DR severity per modified Davis staging. No pharmacologic dilation. Posterior pole photograph:
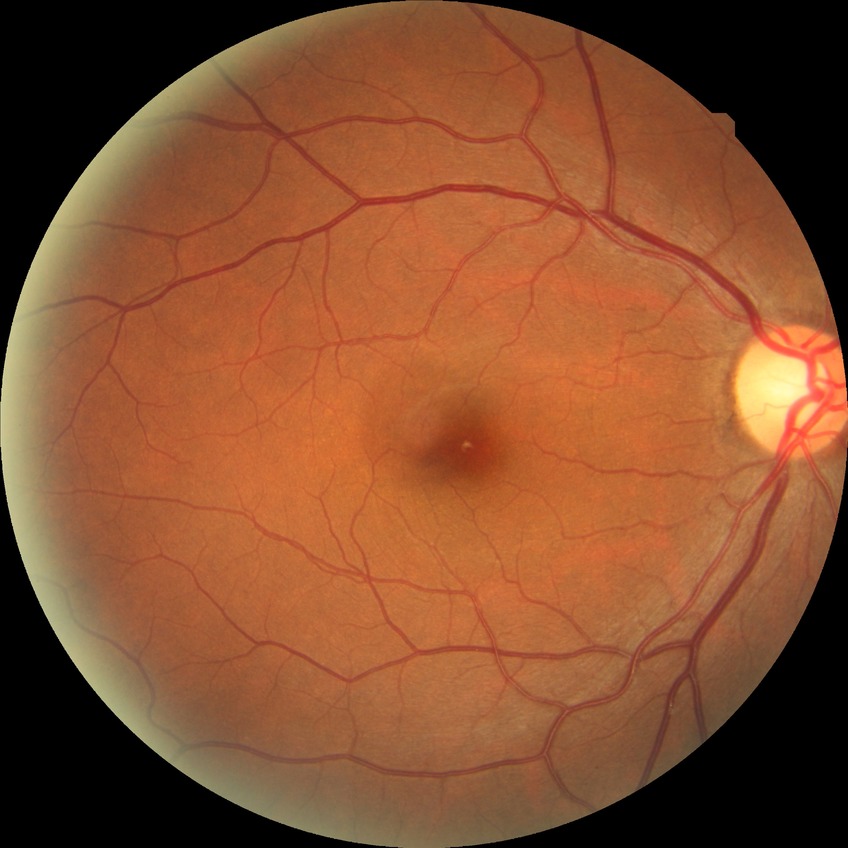 Diabetic retinopathy (DR): no diabetic retinopathy (NDR).